Captured after pupil dilation
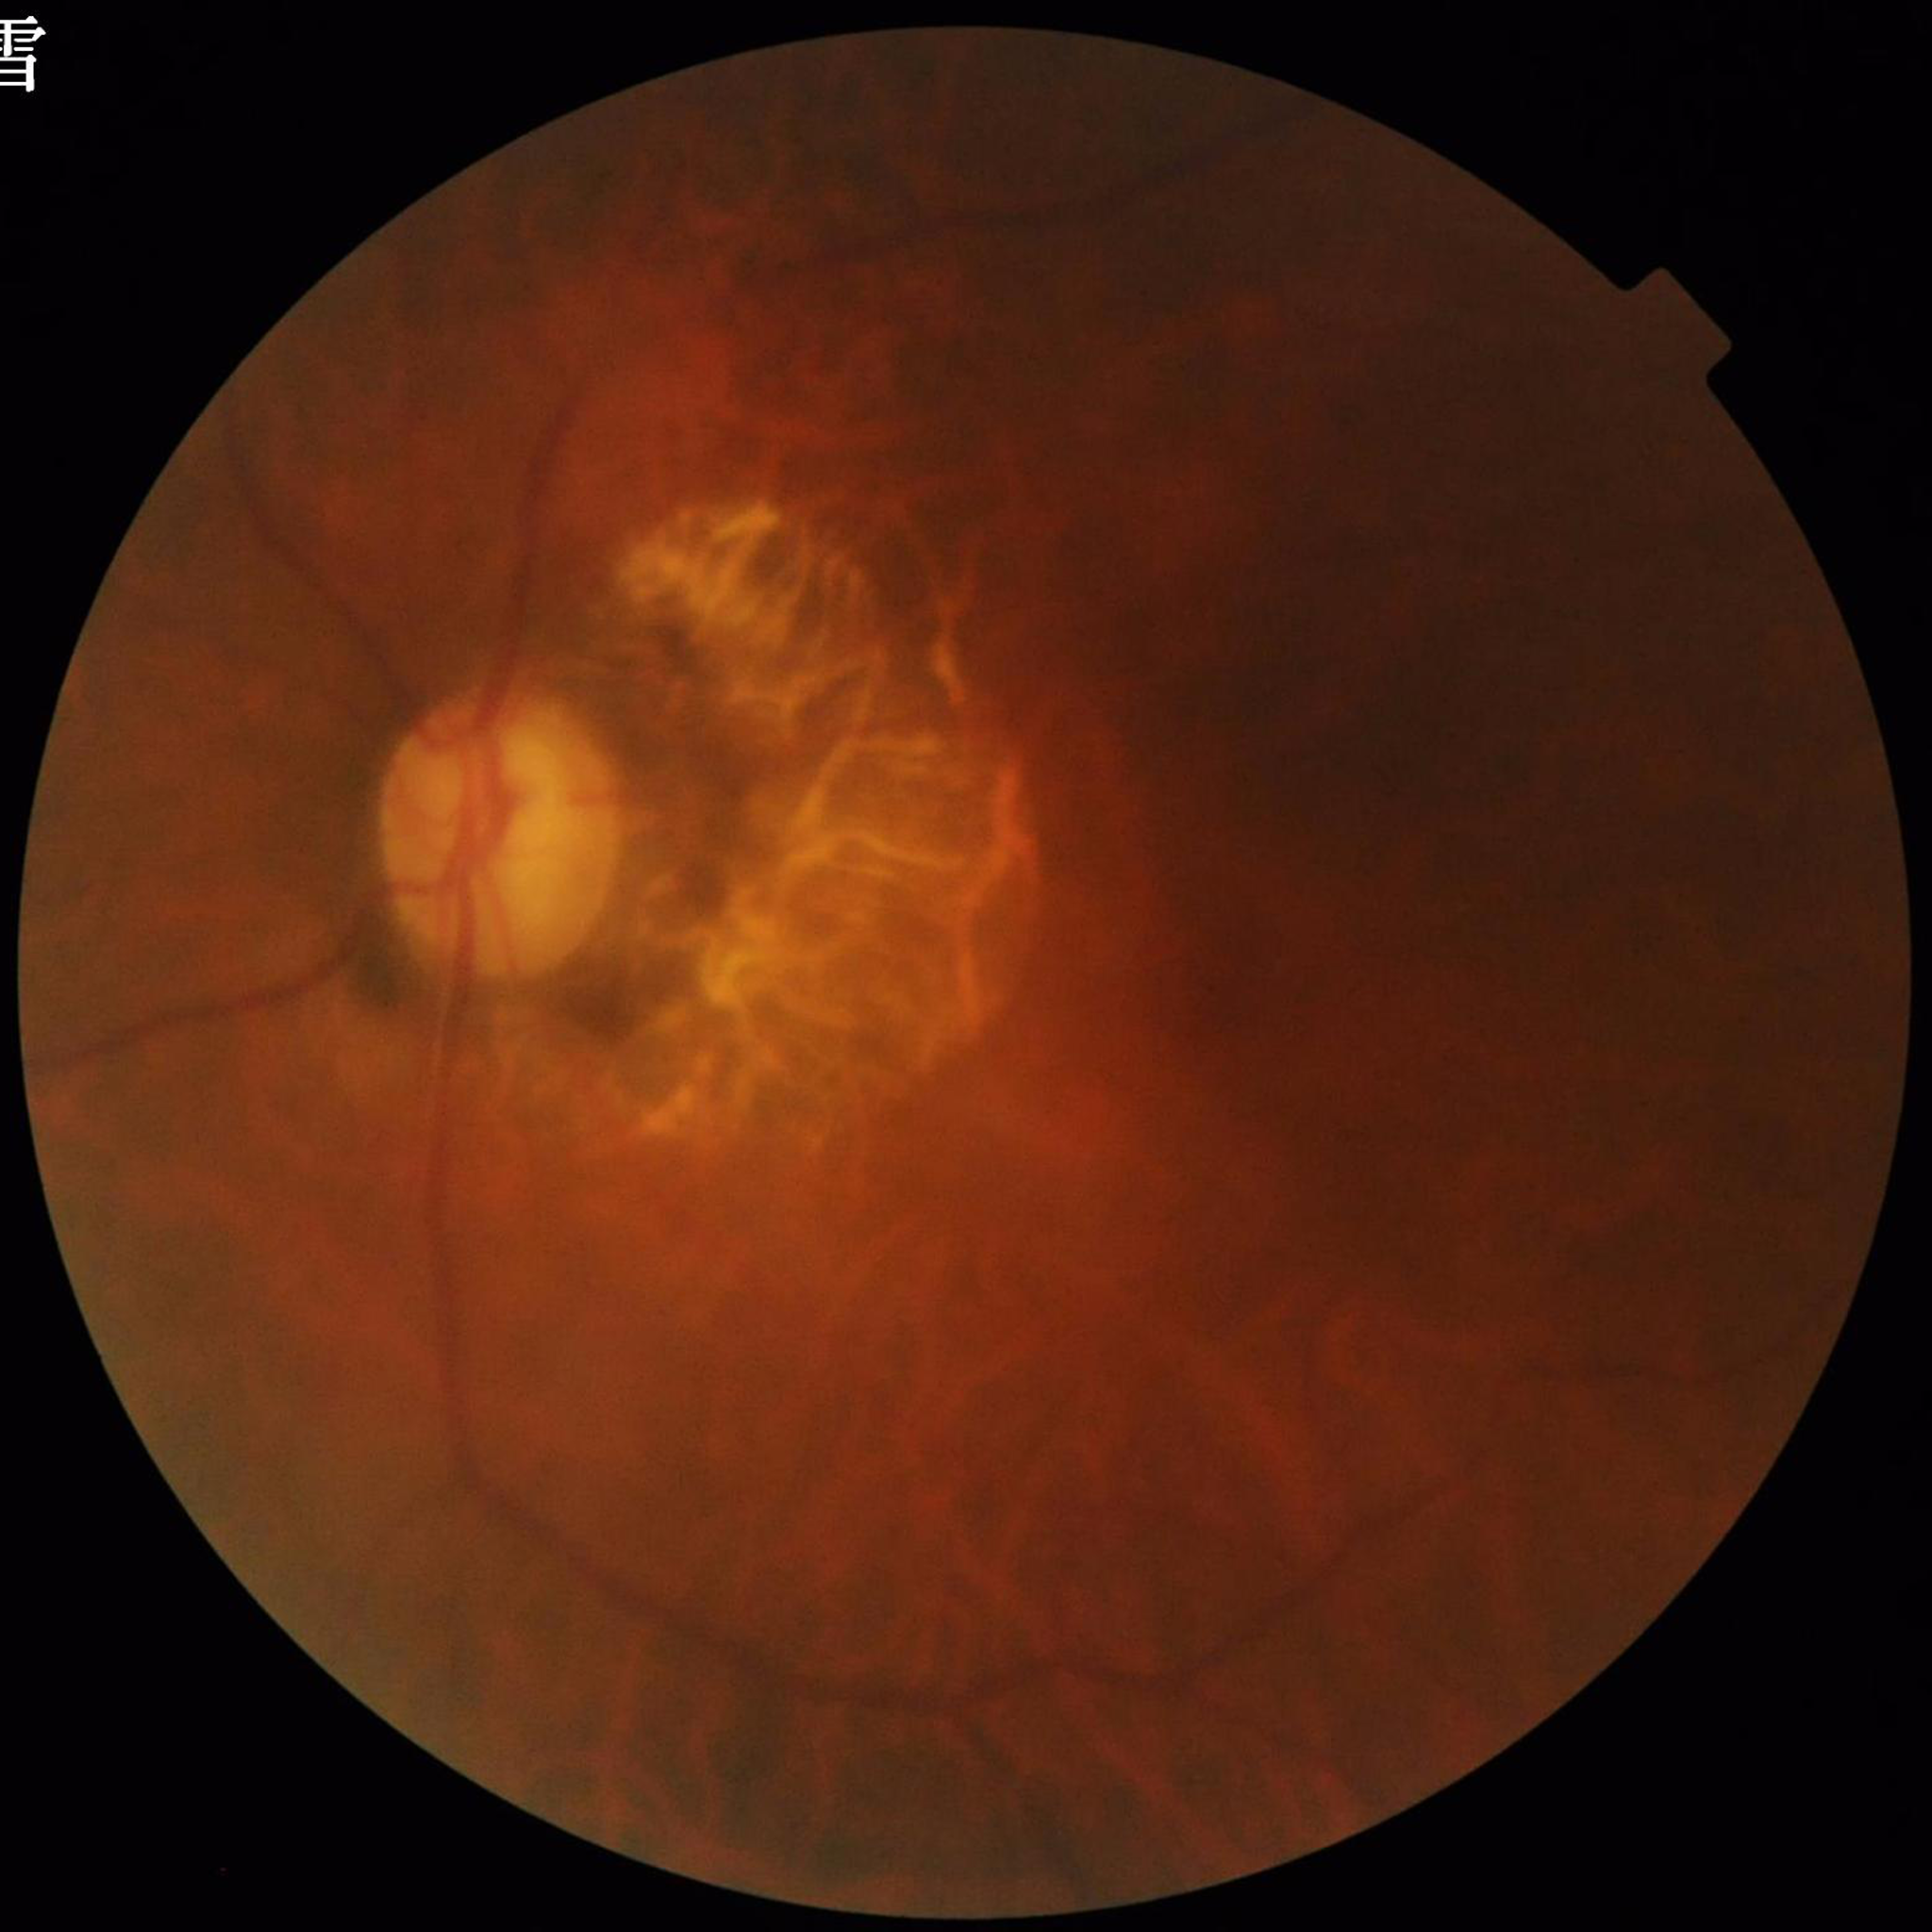 Quality: poor — blur.
Retinal fundus photograph from a patient with glaucoma.